2048x1536, 45° FOV:
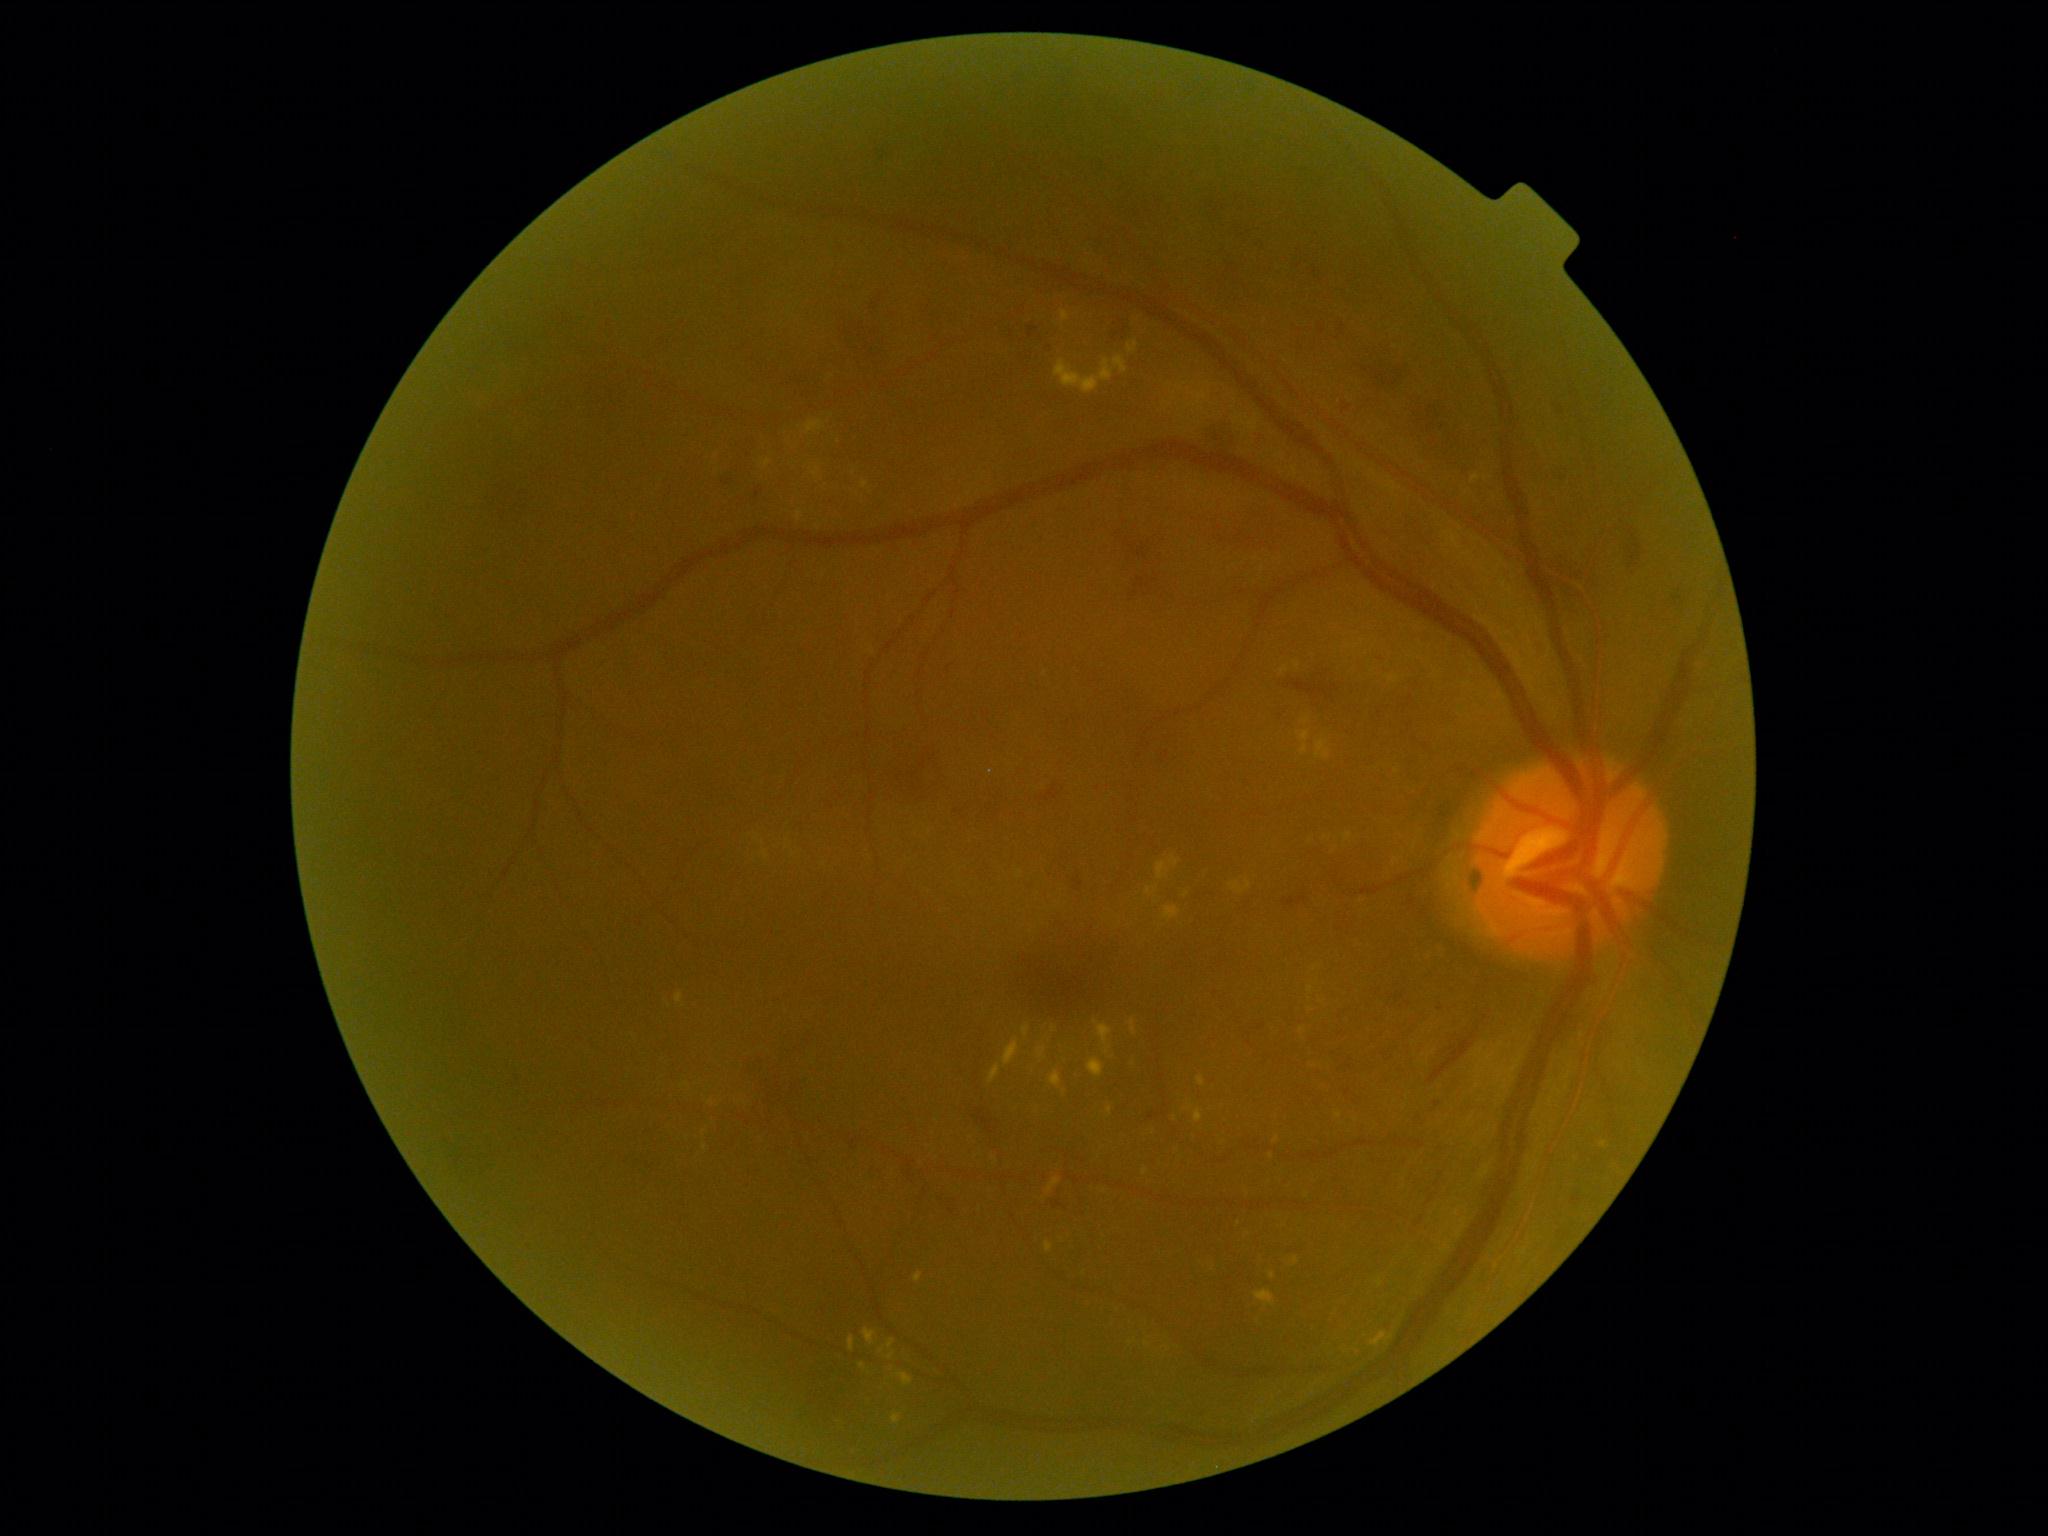

Diabetic retinopathy (DR): 2 — more than just microaneurysms but less than severe NPDR
Selected lesions:
- hard exudates (EXs) (continued): bbox=(797, 510, 804, 521), bbox=(1335, 1113, 1343, 1119), bbox=(861, 481, 868, 489), bbox=(1163, 907, 1182, 921), bbox=(1037, 1048, 1046, 1059), bbox=(1230, 879, 1252, 894), bbox=(1047, 1179, 1062, 1195), bbox=(1344, 832, 1353, 842), bbox=(1128, 341, 1139, 354), bbox=(1371, 1332, 1394, 1348), bbox=(1131, 1020, 1138, 1036), bbox=(1292, 1258, 1300, 1266)
- Small EXs near <pt>995,1159</pt>, <pt>838,442</pt>, <pt>1321,1002</pt>, <pt>1175,1118</pt>, <pt>1189,1109</pt>, <pt>1277,1140</pt>, <pt>1307,722</pt>